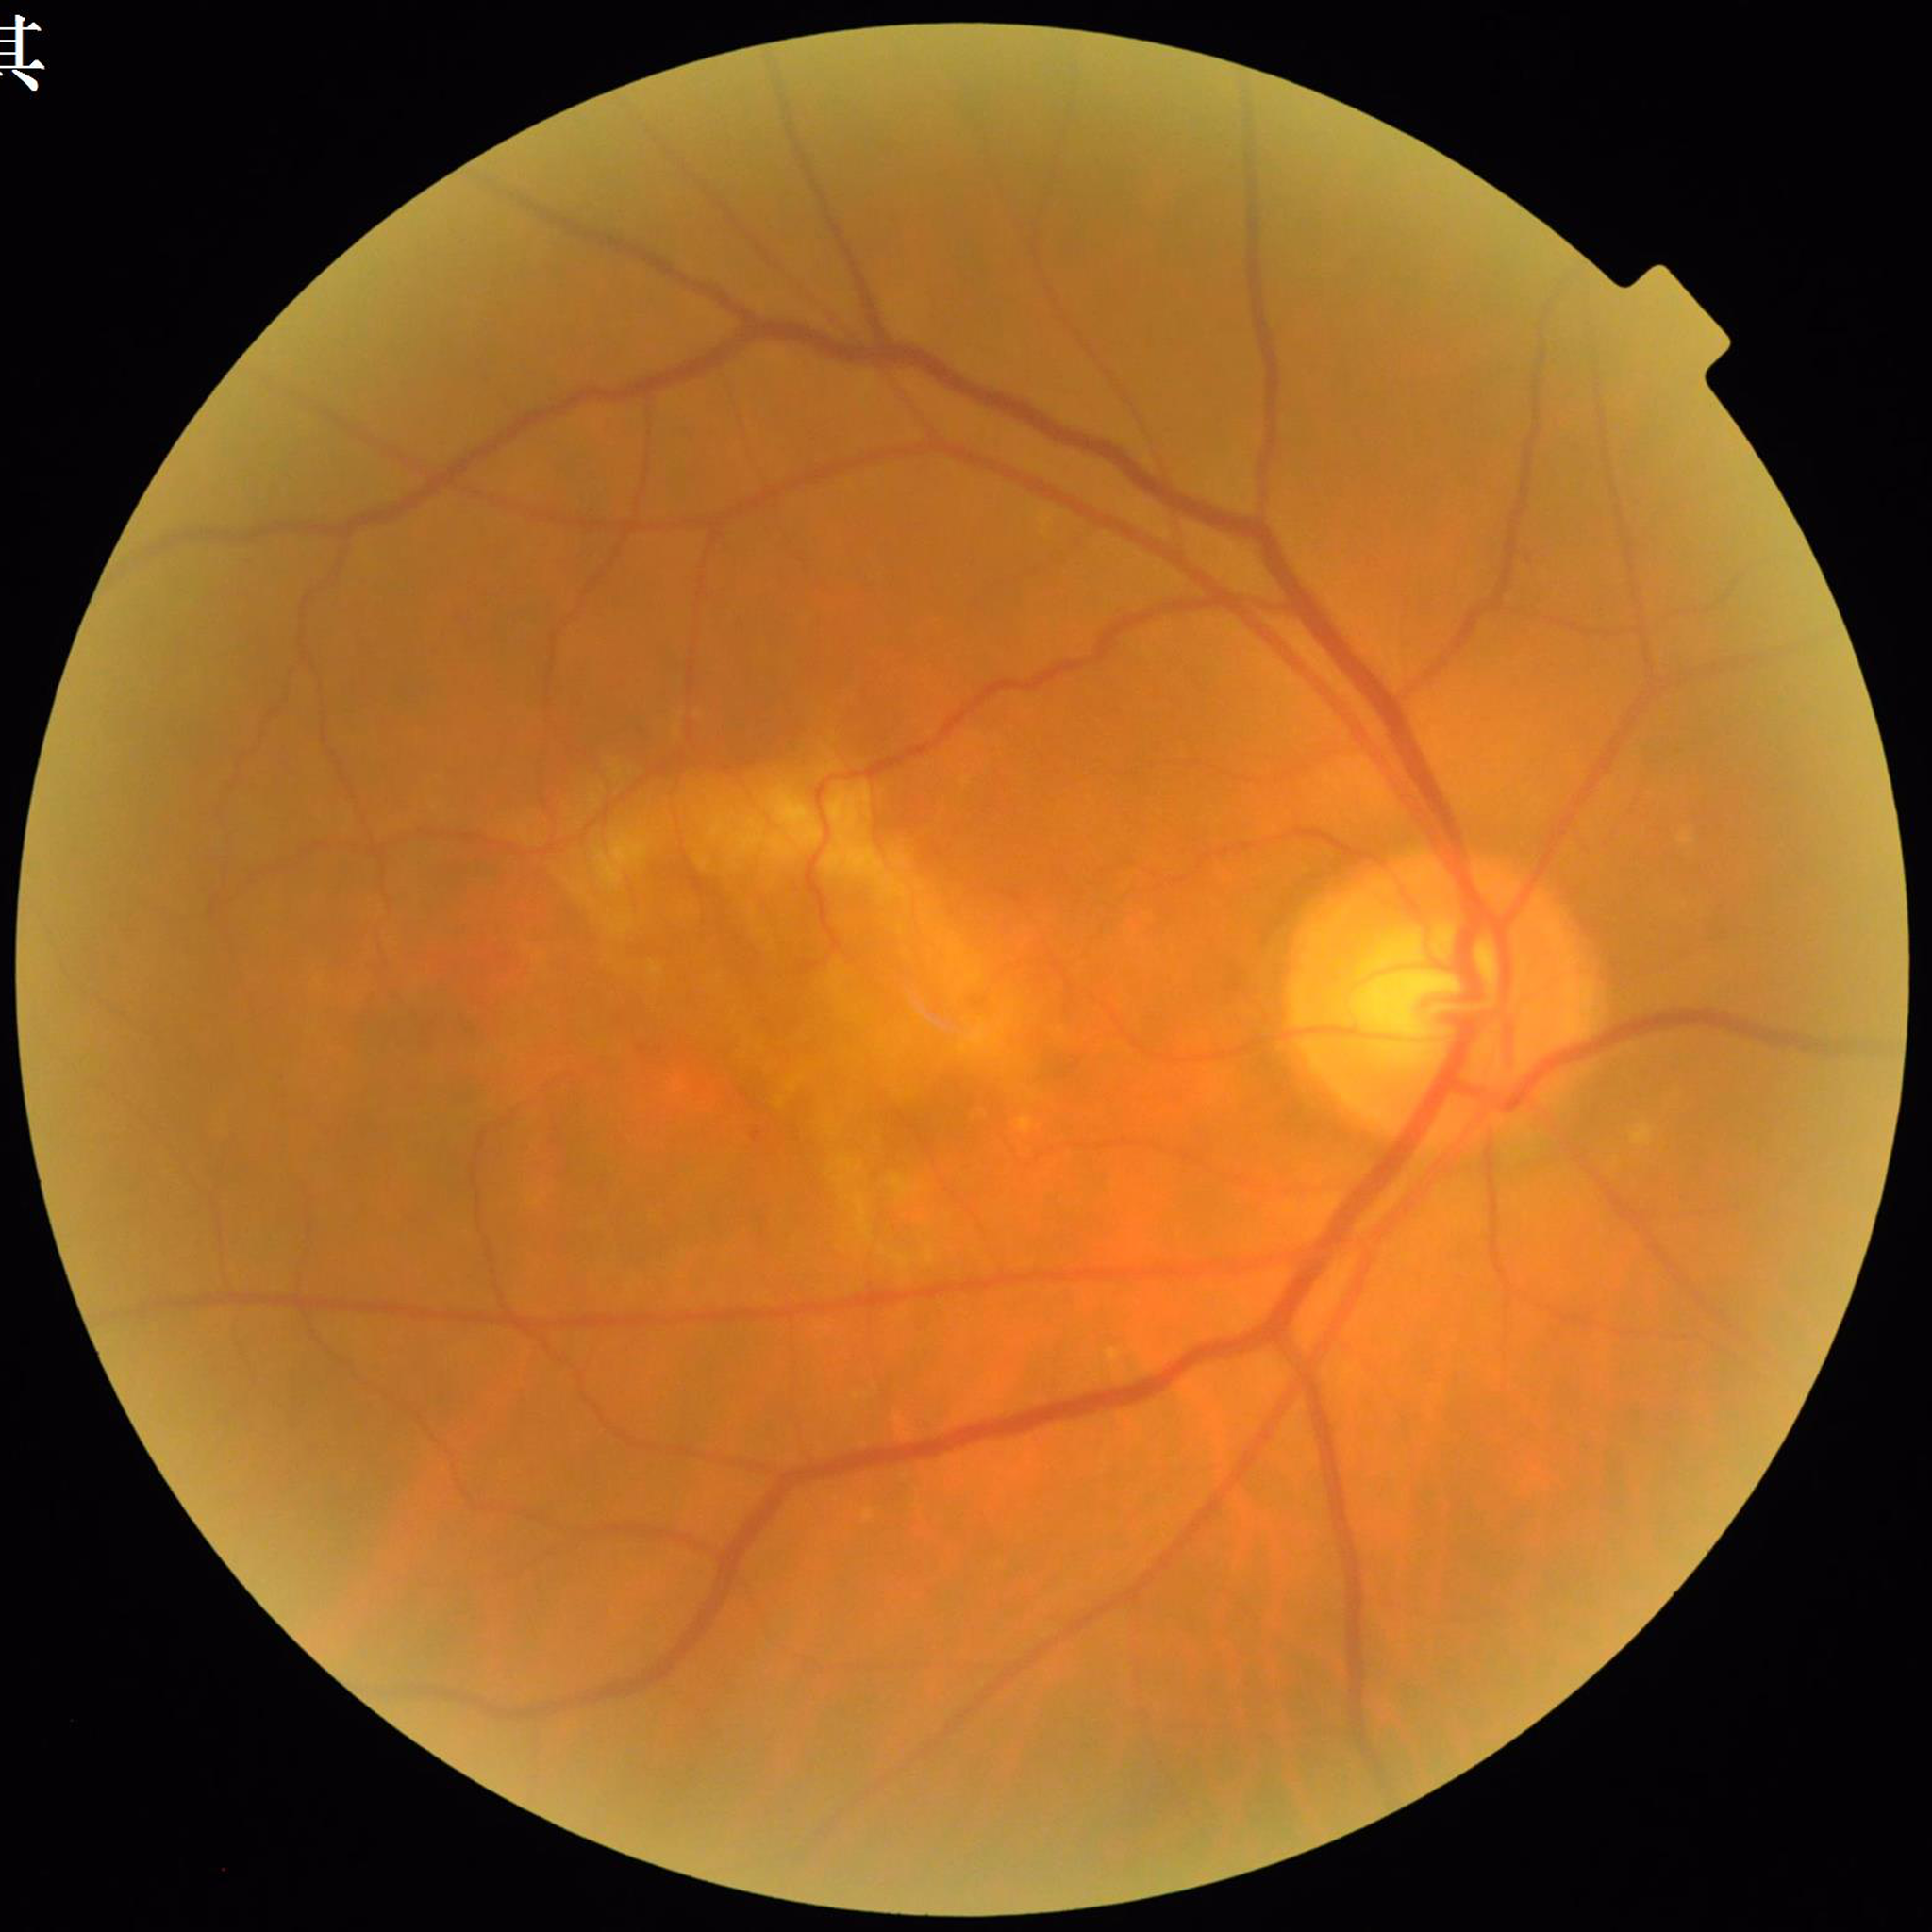 Disease: age-related macular degeneration
Quality: suboptimal — illumination/color distortion